45° field of view · CFP · 2352 by 1568 pixels.
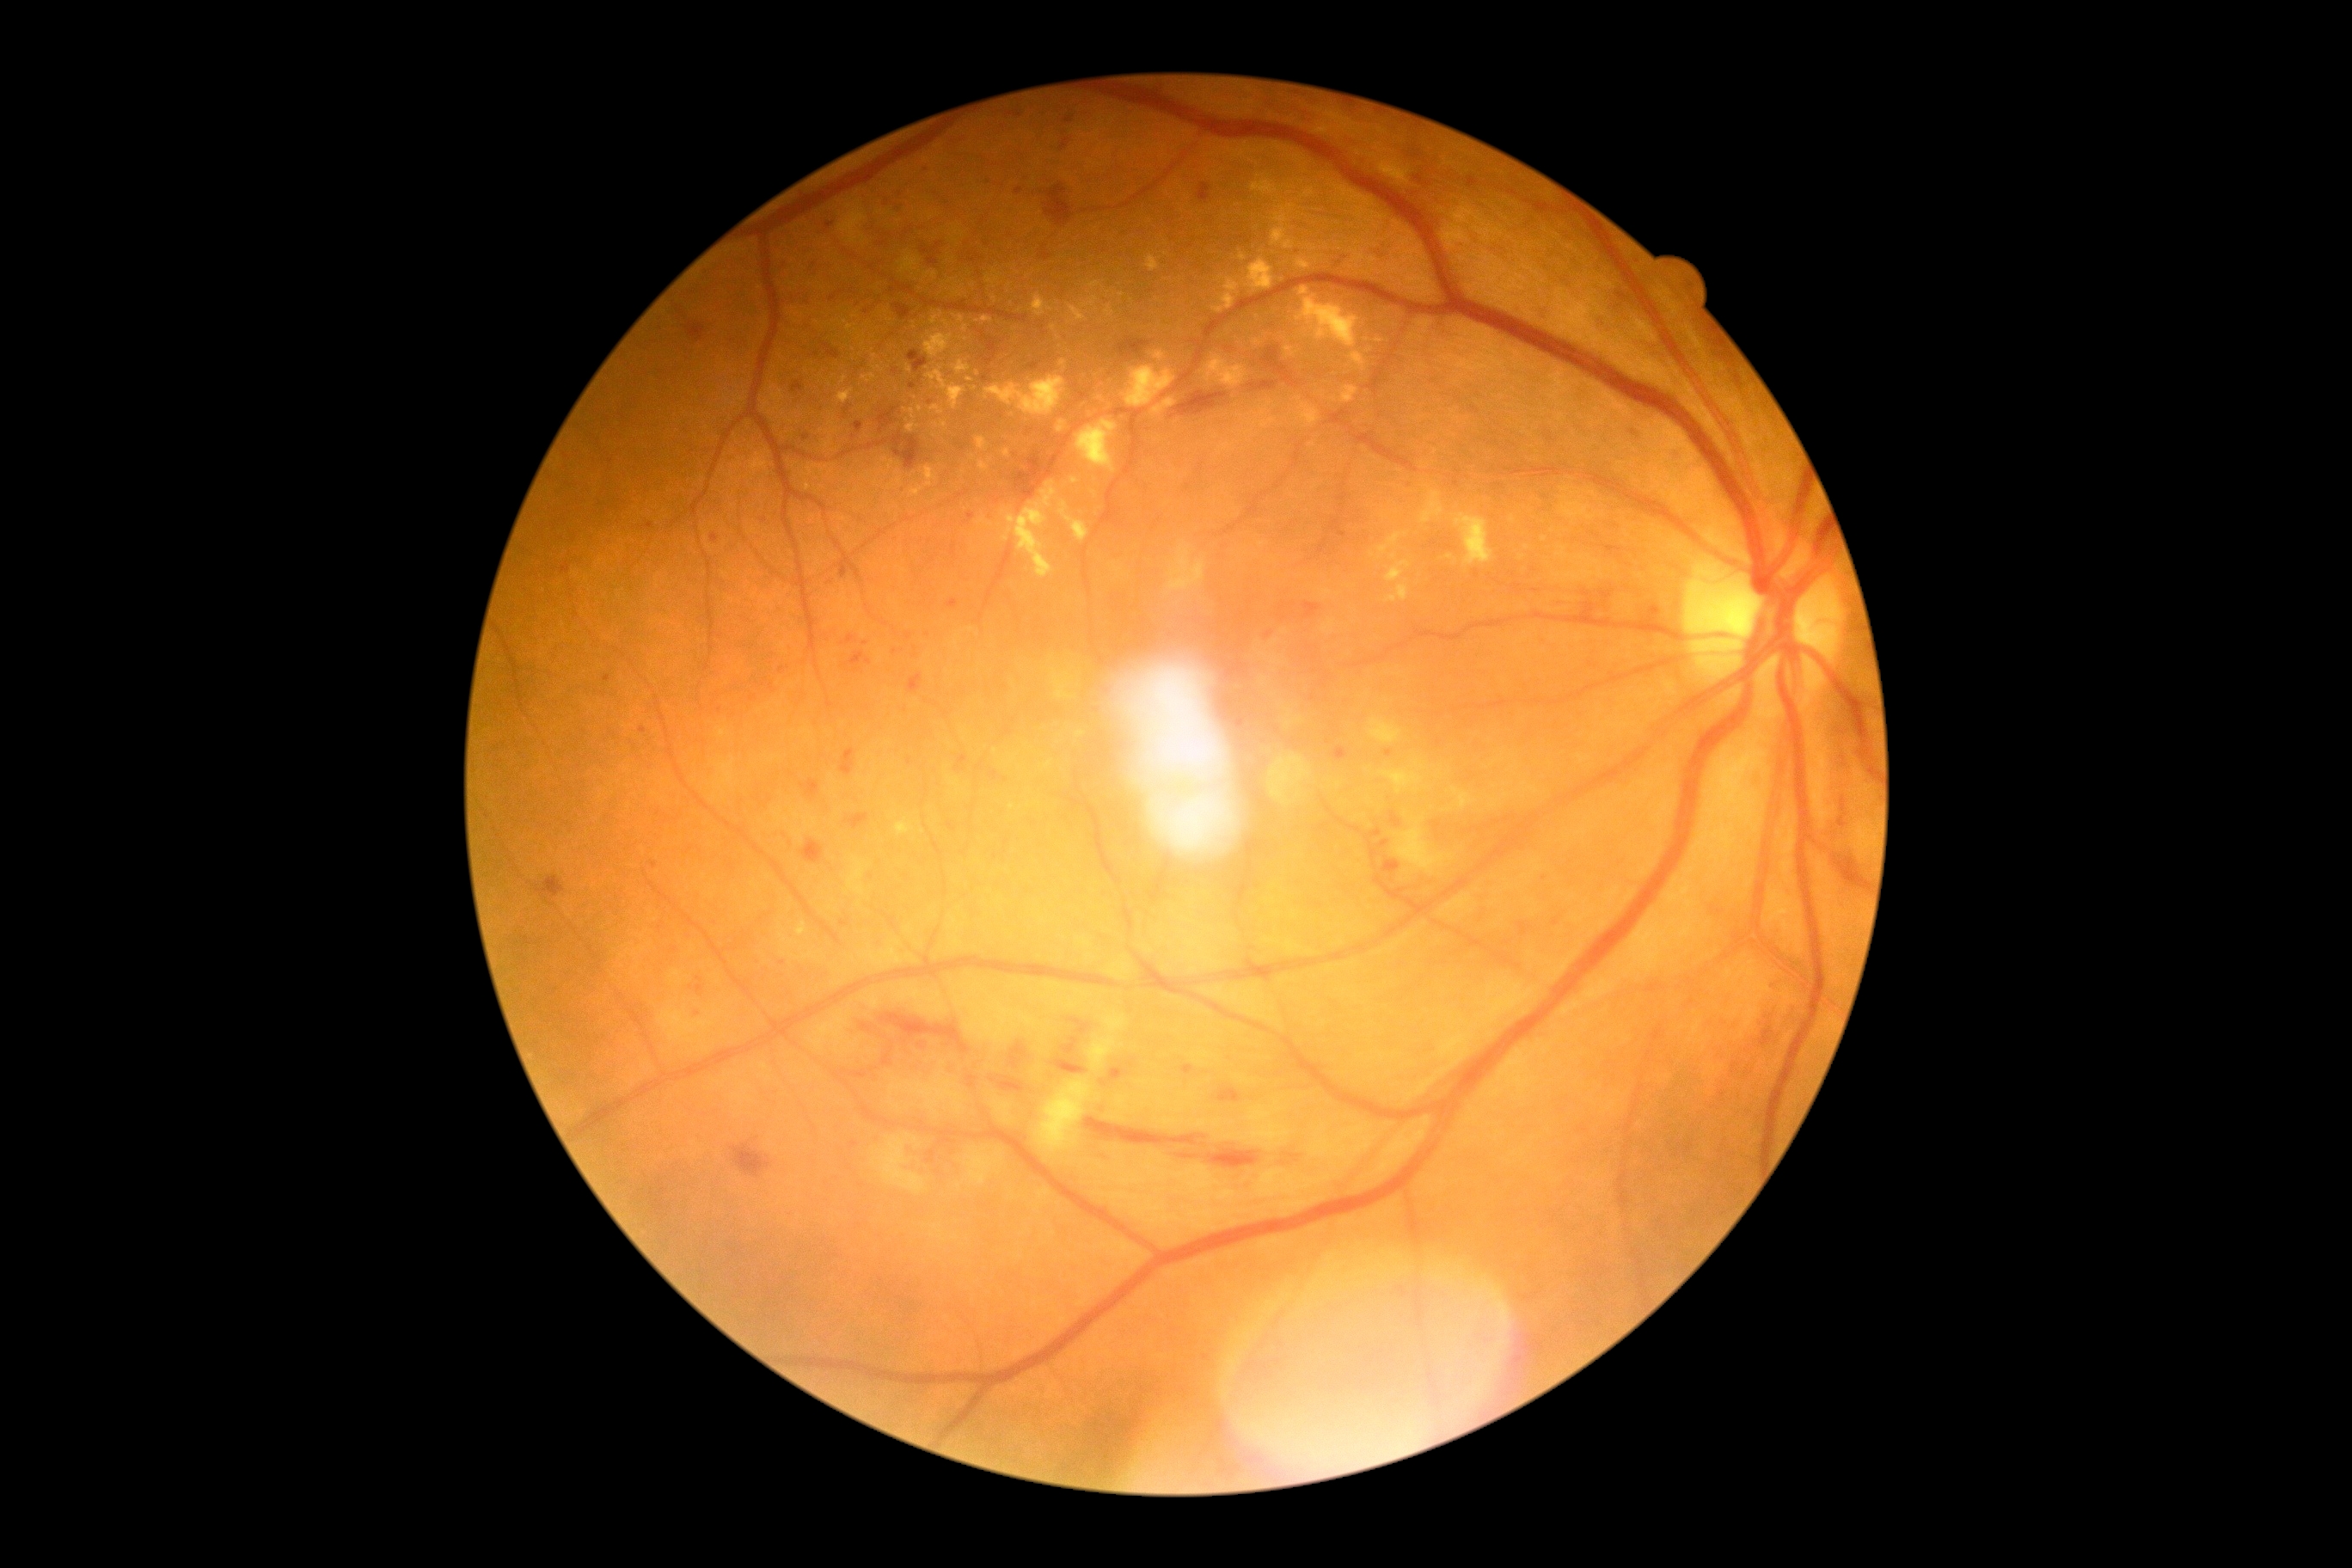
The retinopathy is classified as non-proliferative diabetic retinopathy.
Diabetic retinopathy grade is severe NPDR (3) — more than 20 intraretinal hemorrhages in each of 4 quadrants, definite venous beading in 2 or more quadrants, or prominent intraretinal microvascular abnormalities in 1 or more quadrants, with no signs of proliferative retinopathy.